Image size 1440x1080. Pediatric wide-field fundus photograph.
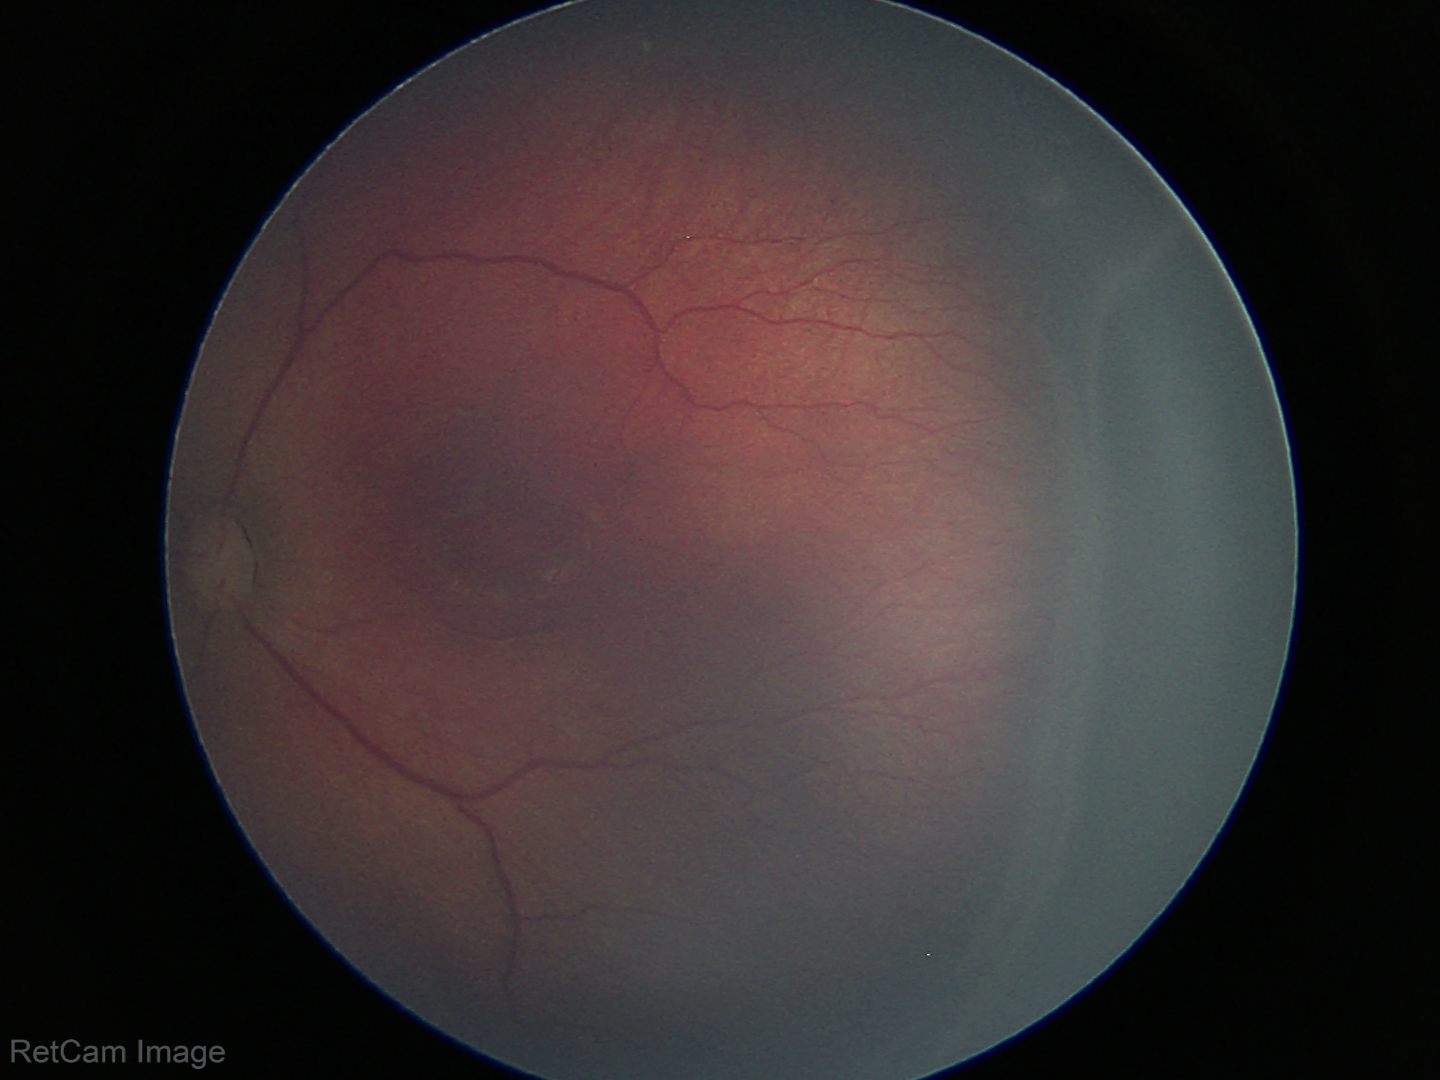 ROP = stage 3
plus disease = absent